Image size 1932x1916, retinal fundus photograph, 45-degree field of view: 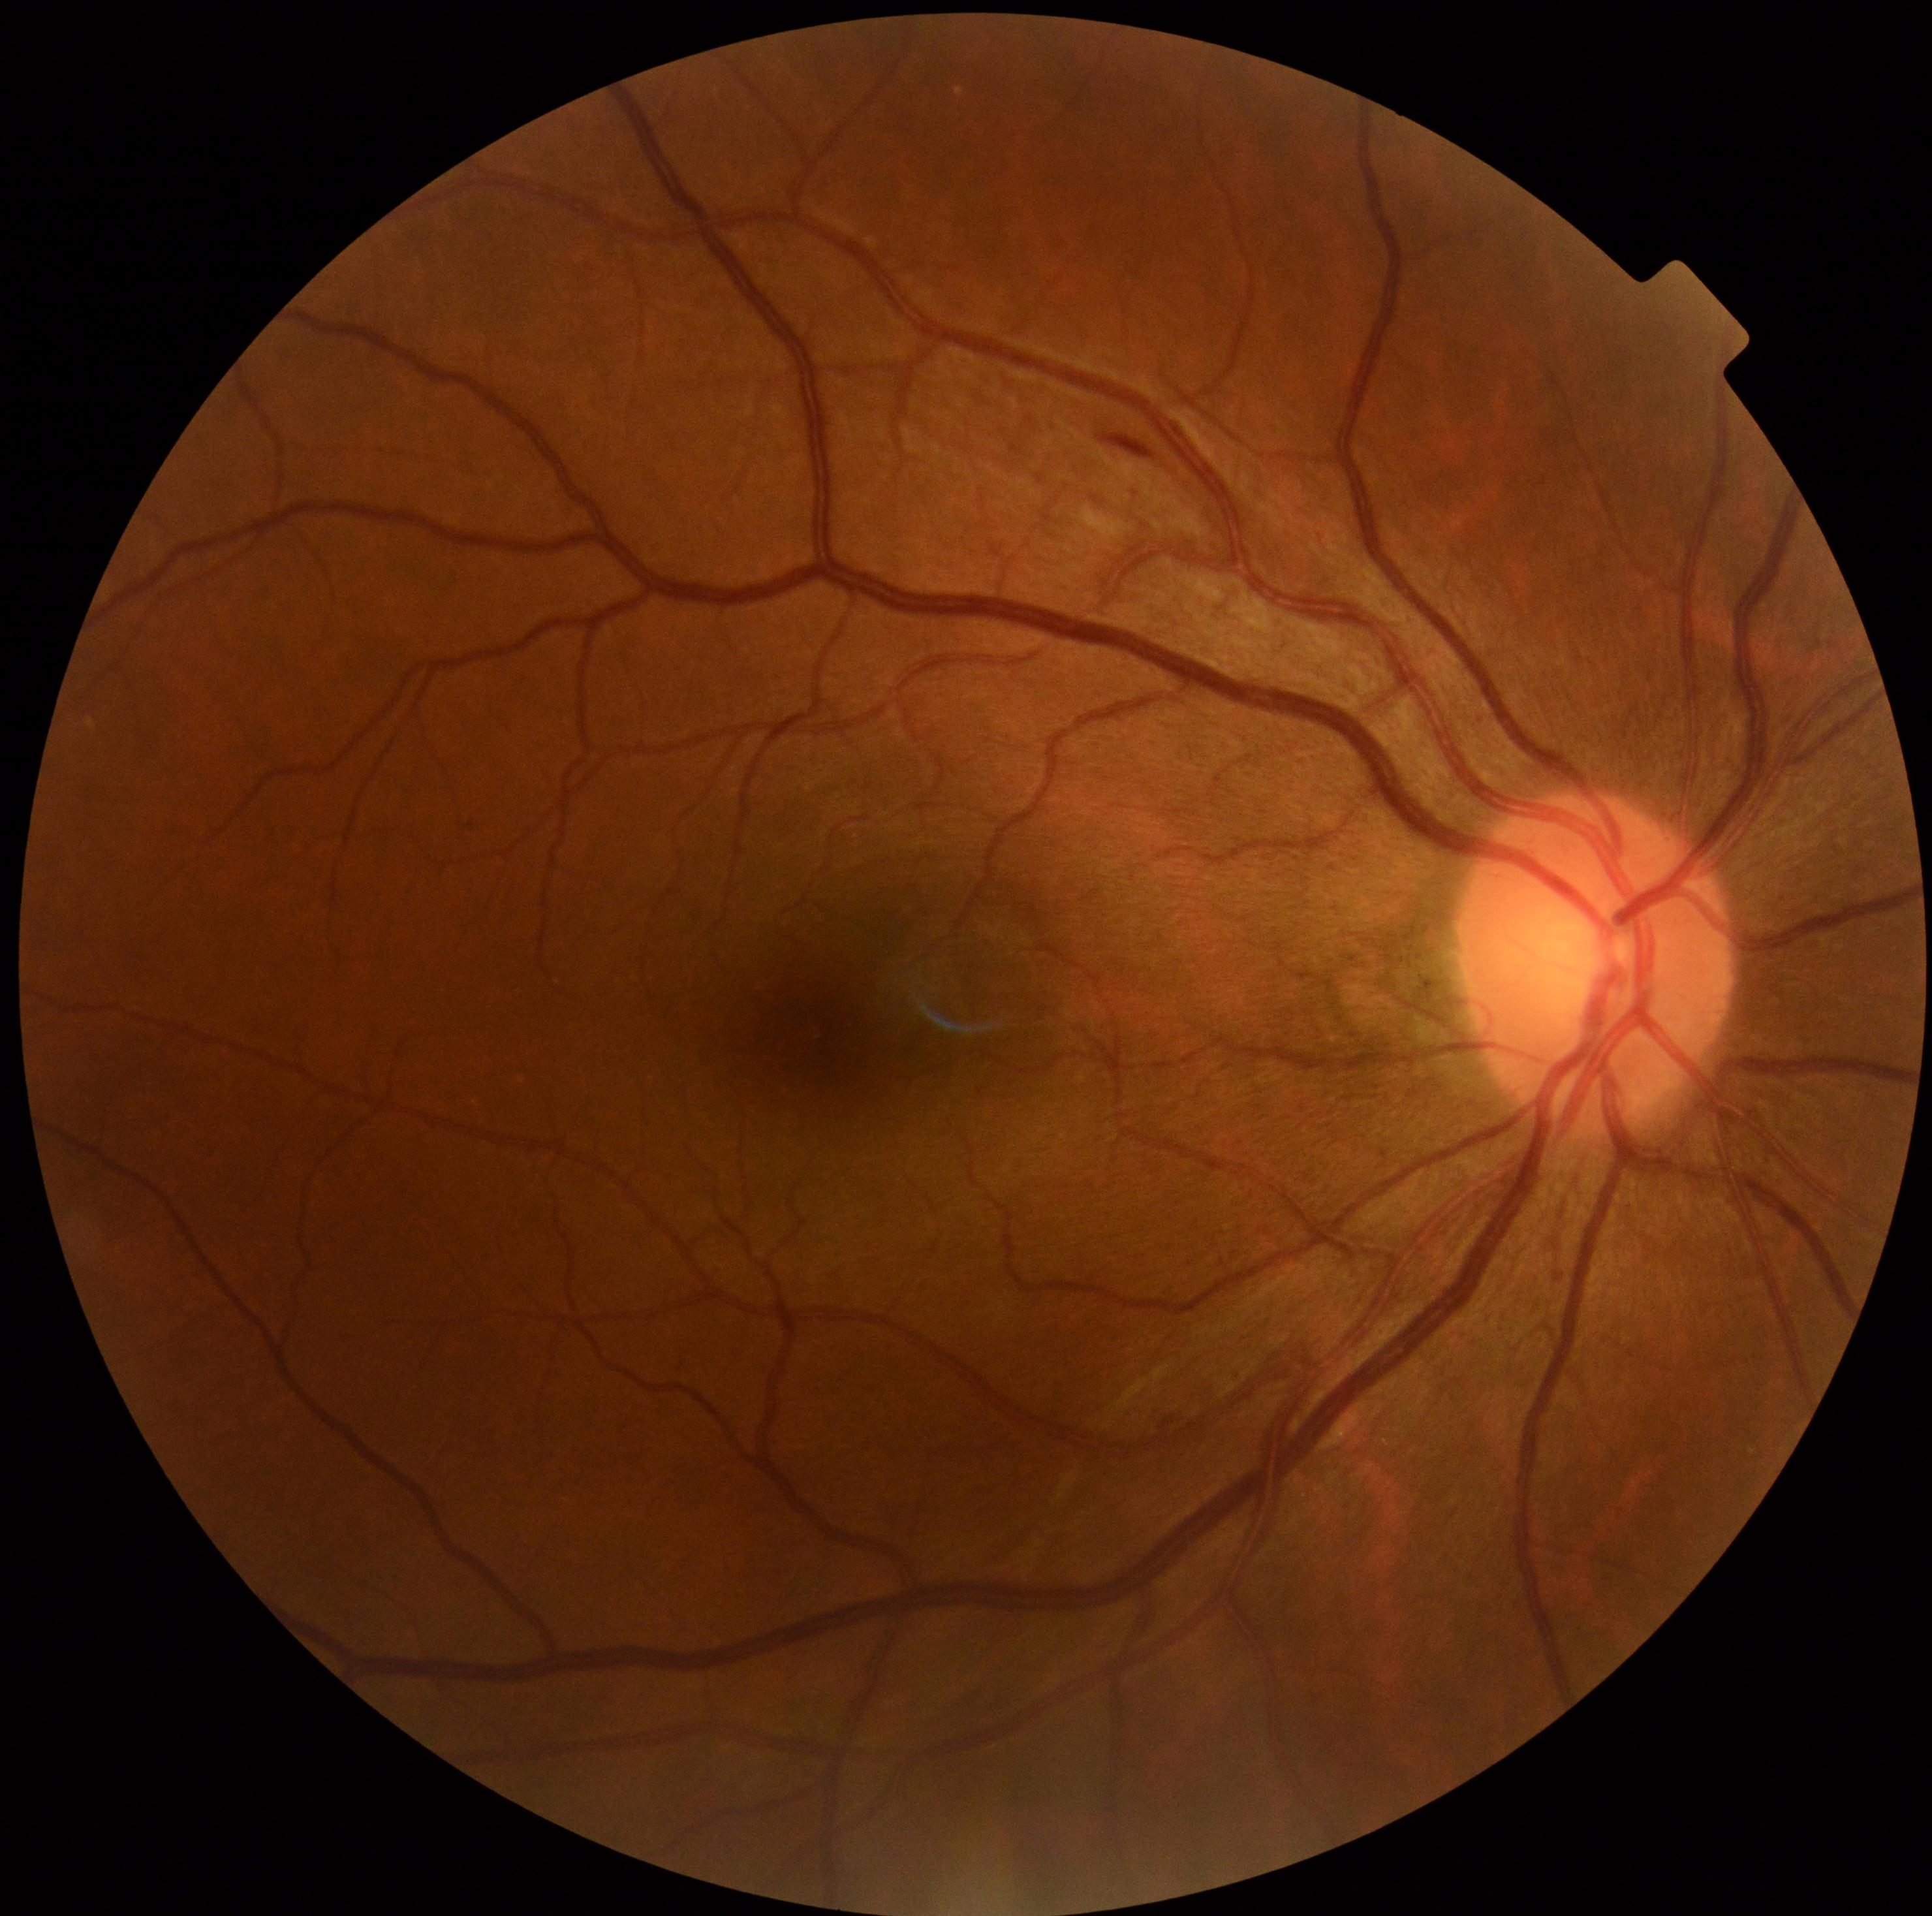 DR severity: grade 2 (moderate NPDR).